Pediatric retinal photograph (wide-field):
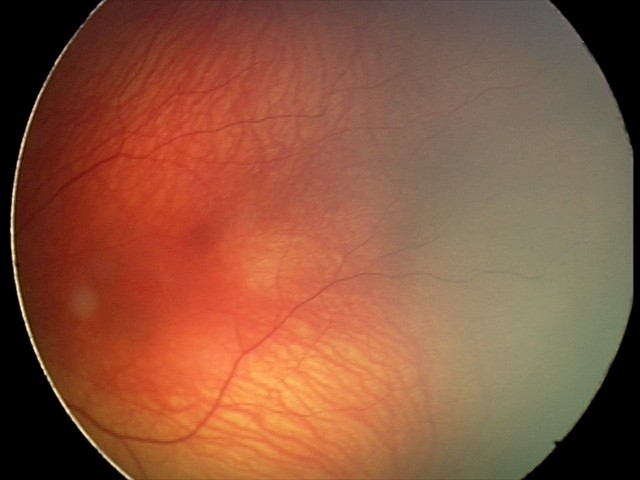 Assessment: normal retinal appearance.